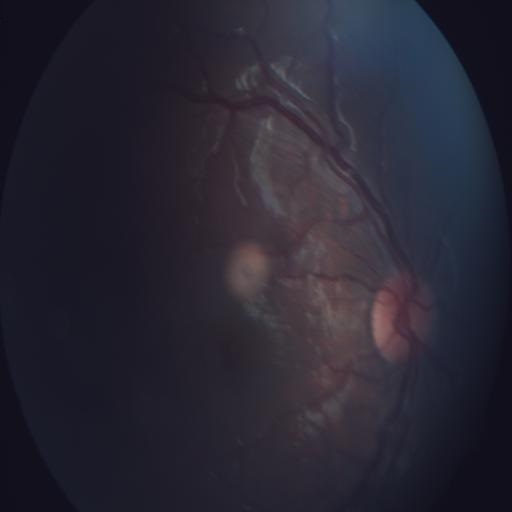

Abnormalities: RS (retinitis).